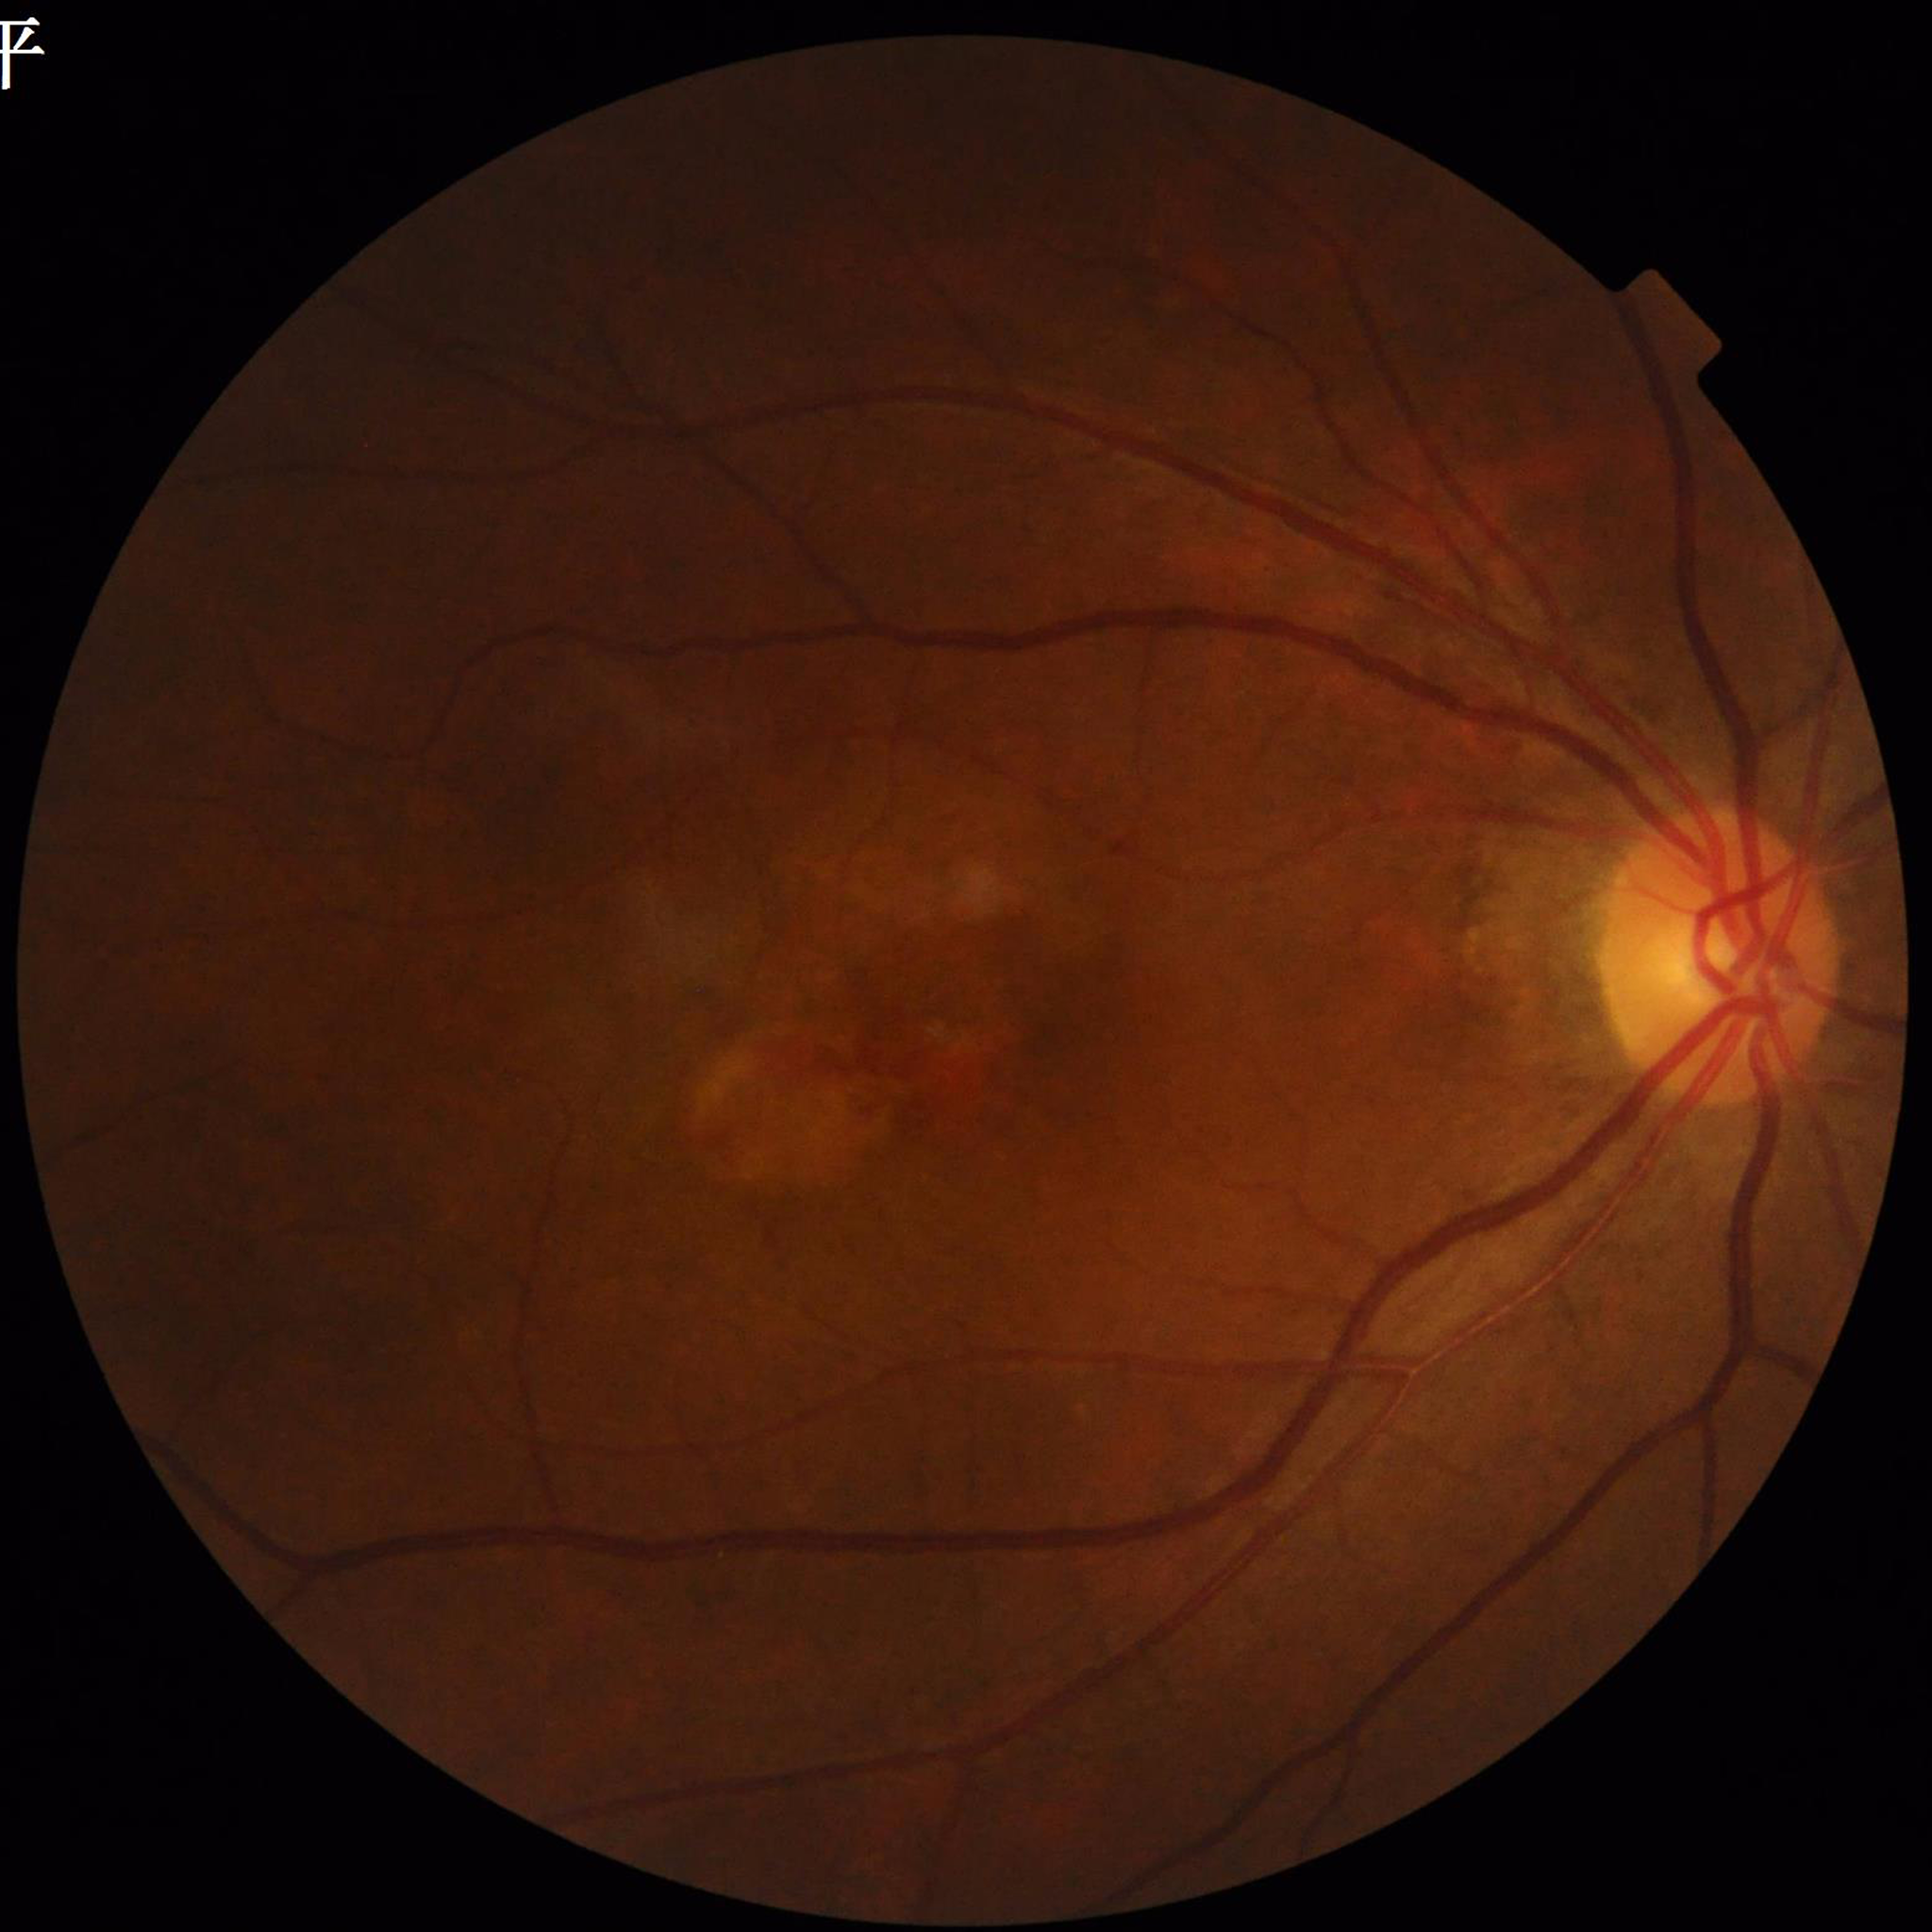

Disease: age-related macular degeneration (AMD).